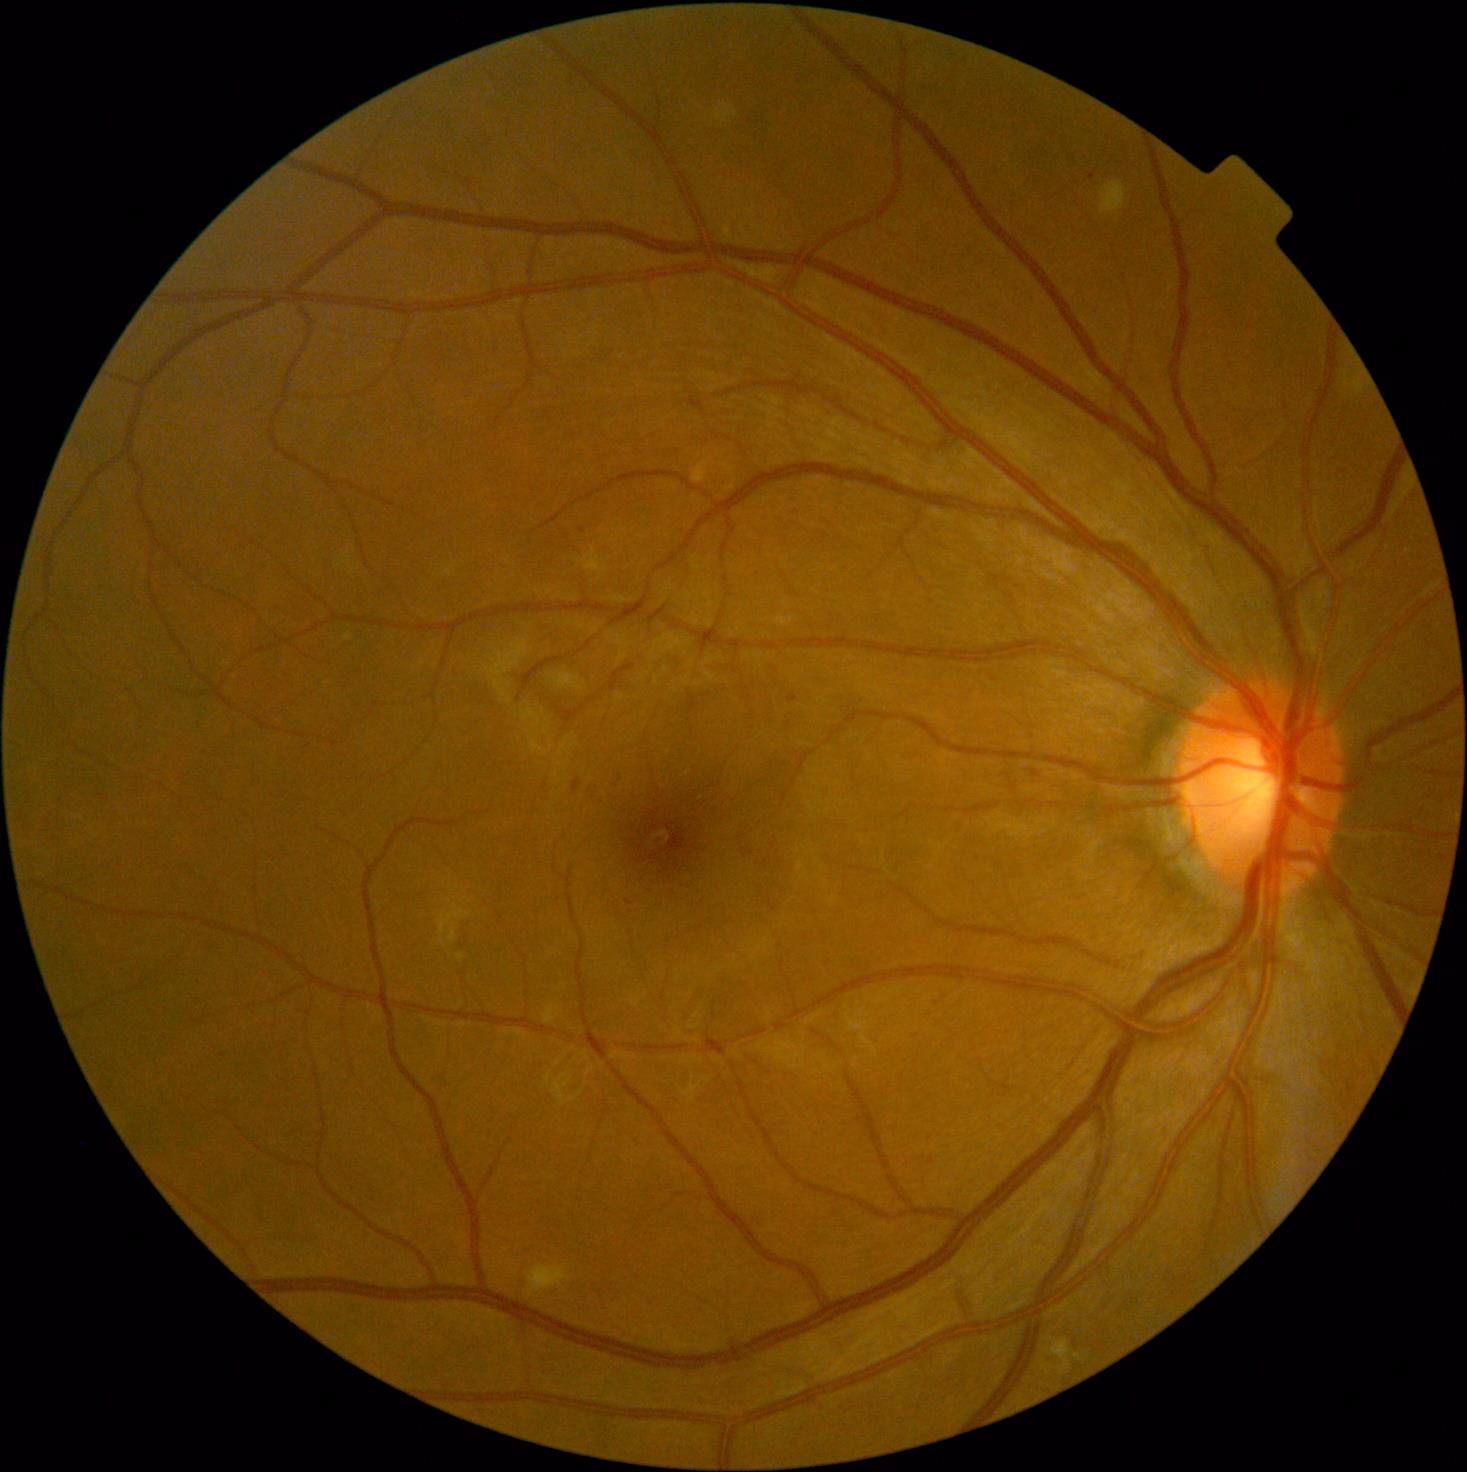

DR grade is 2/4
MAs: <bbox>788, 695, 798, 702</bbox>; <bbox>612, 774, 627, 786</bbox>; <bbox>572, 779, 582, 794</bbox>
Smaller MAs around 1036/774; 1075/1343; 582/531; 629/902
HEs: absent
EXs: absent
SEs: <bbox>527, 1266, 571, 1296</bbox>; <bbox>1100, 181, 1129, 214</bbox>; <bbox>1046, 1339, 1072, 1370</bbox>